2352x1568; 45° field of view: 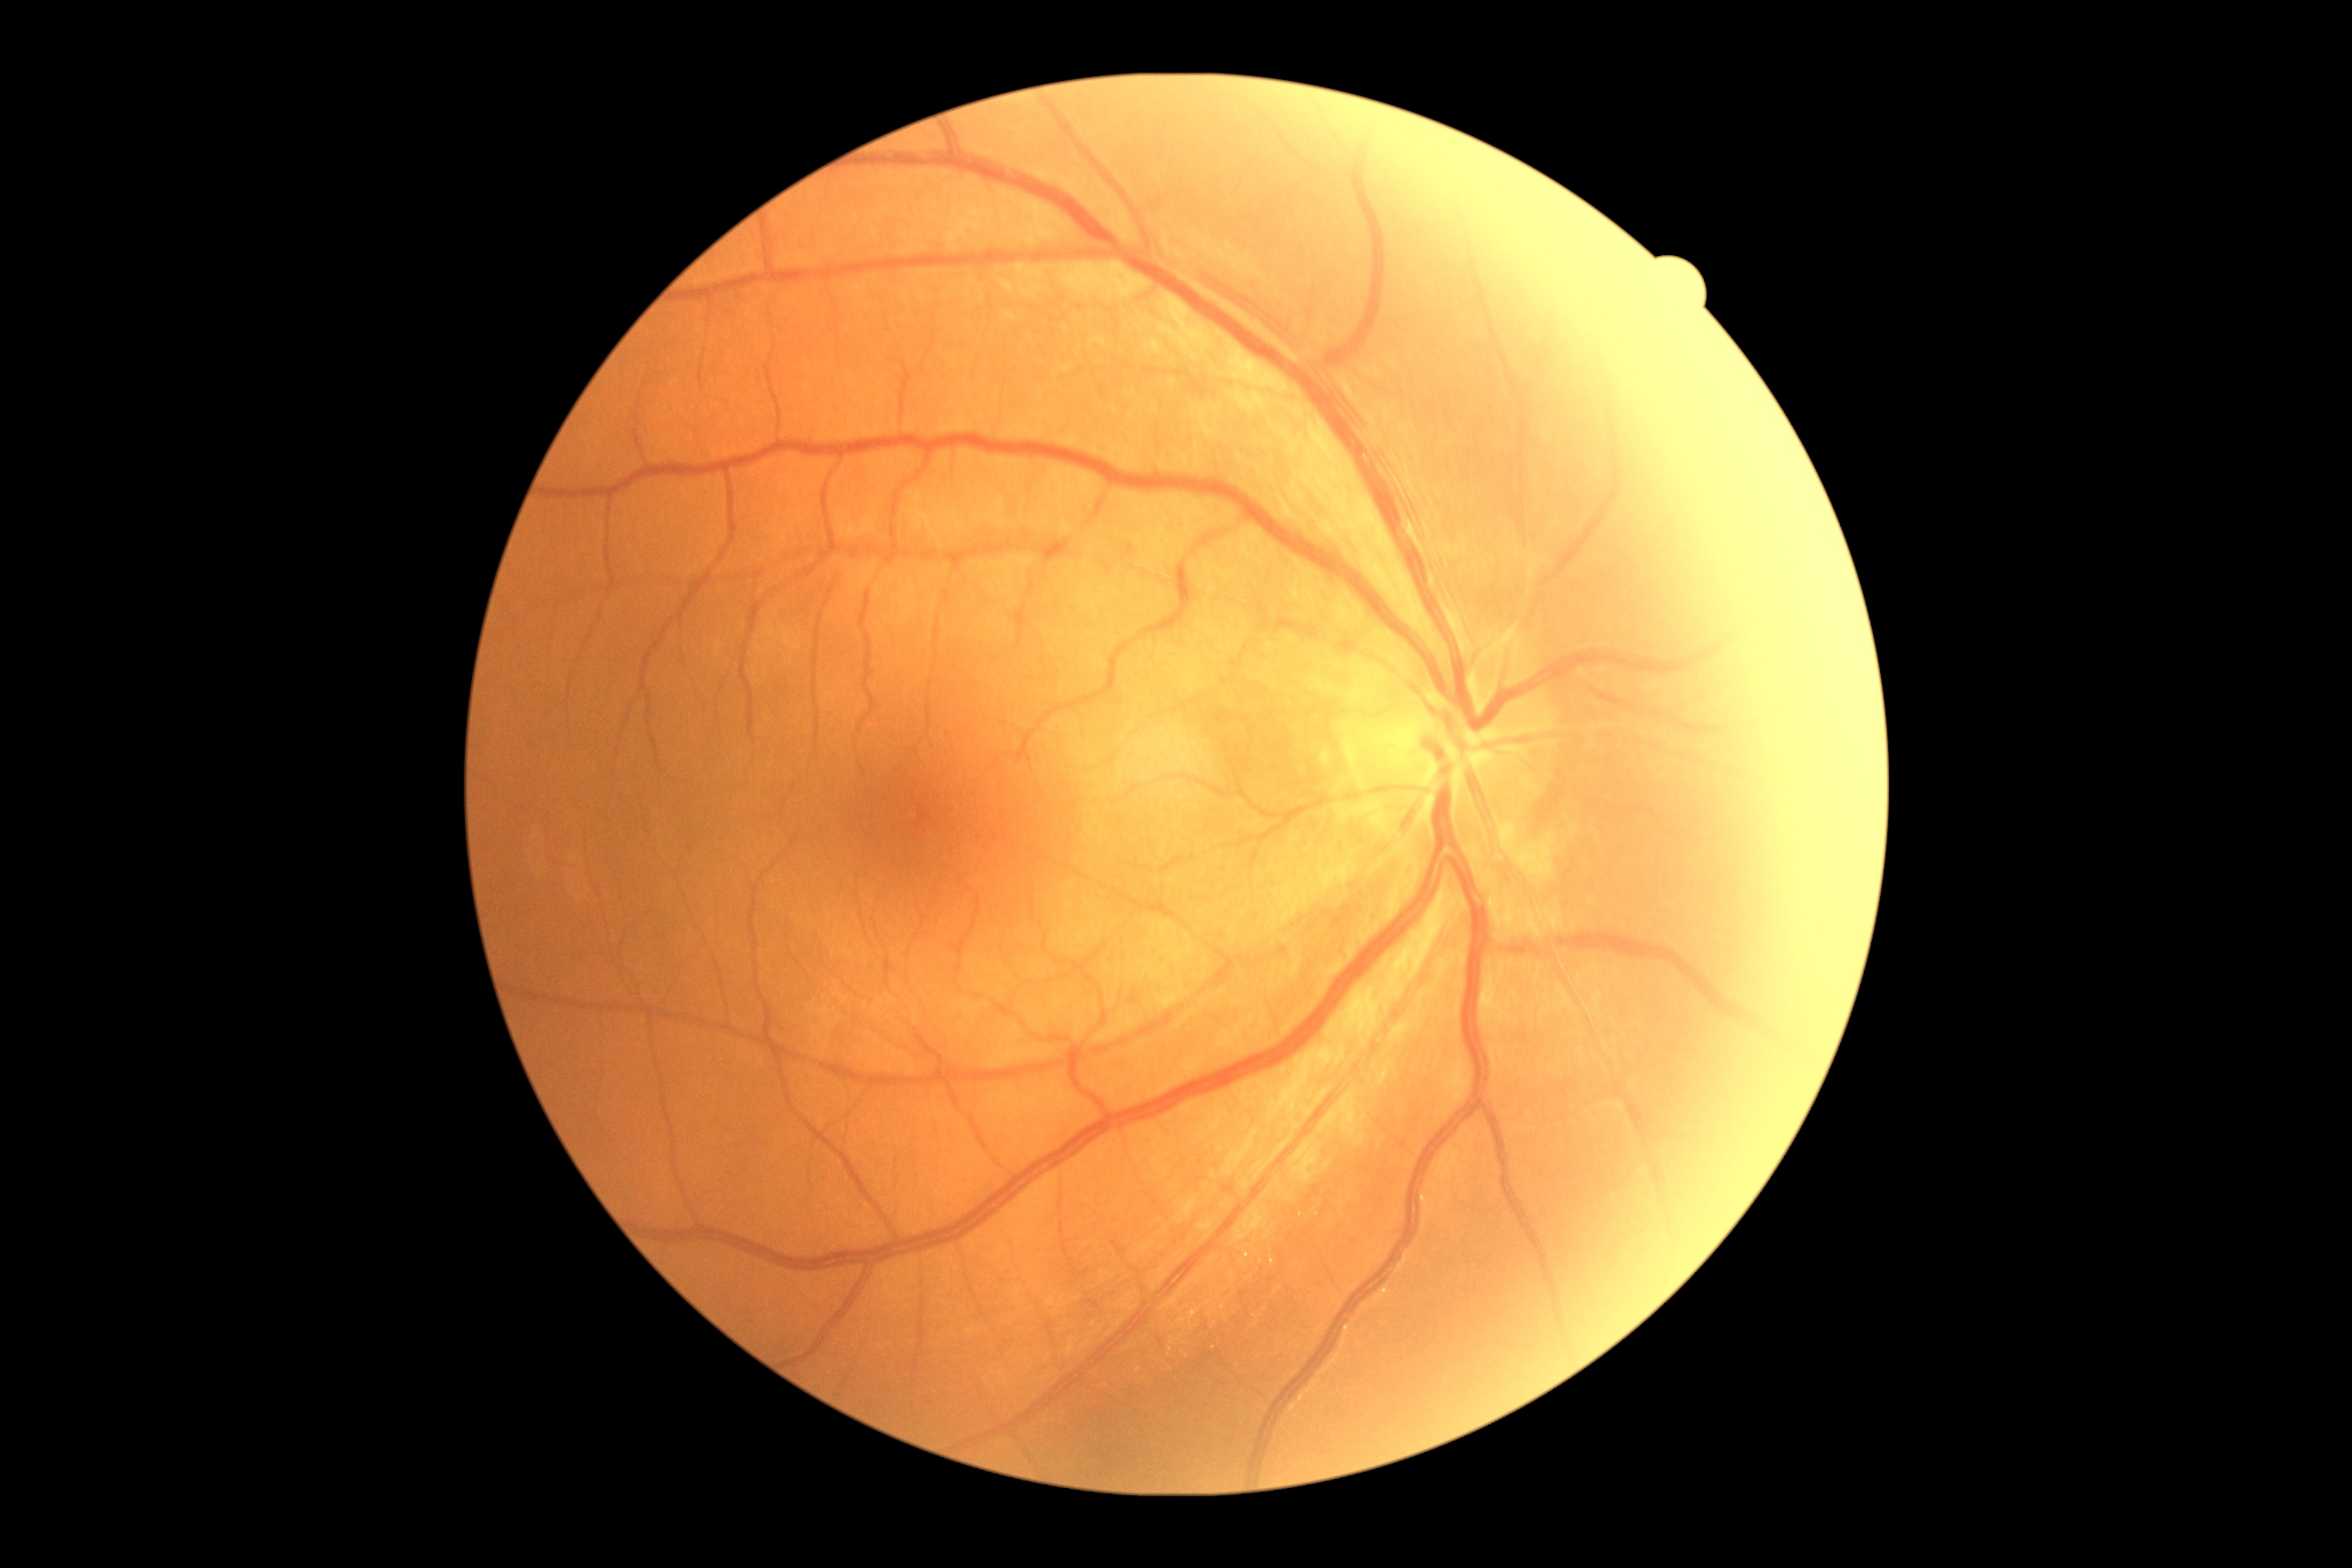
DR severity is no apparent retinopathy (grade 0) — no visible signs of diabetic retinopathy.